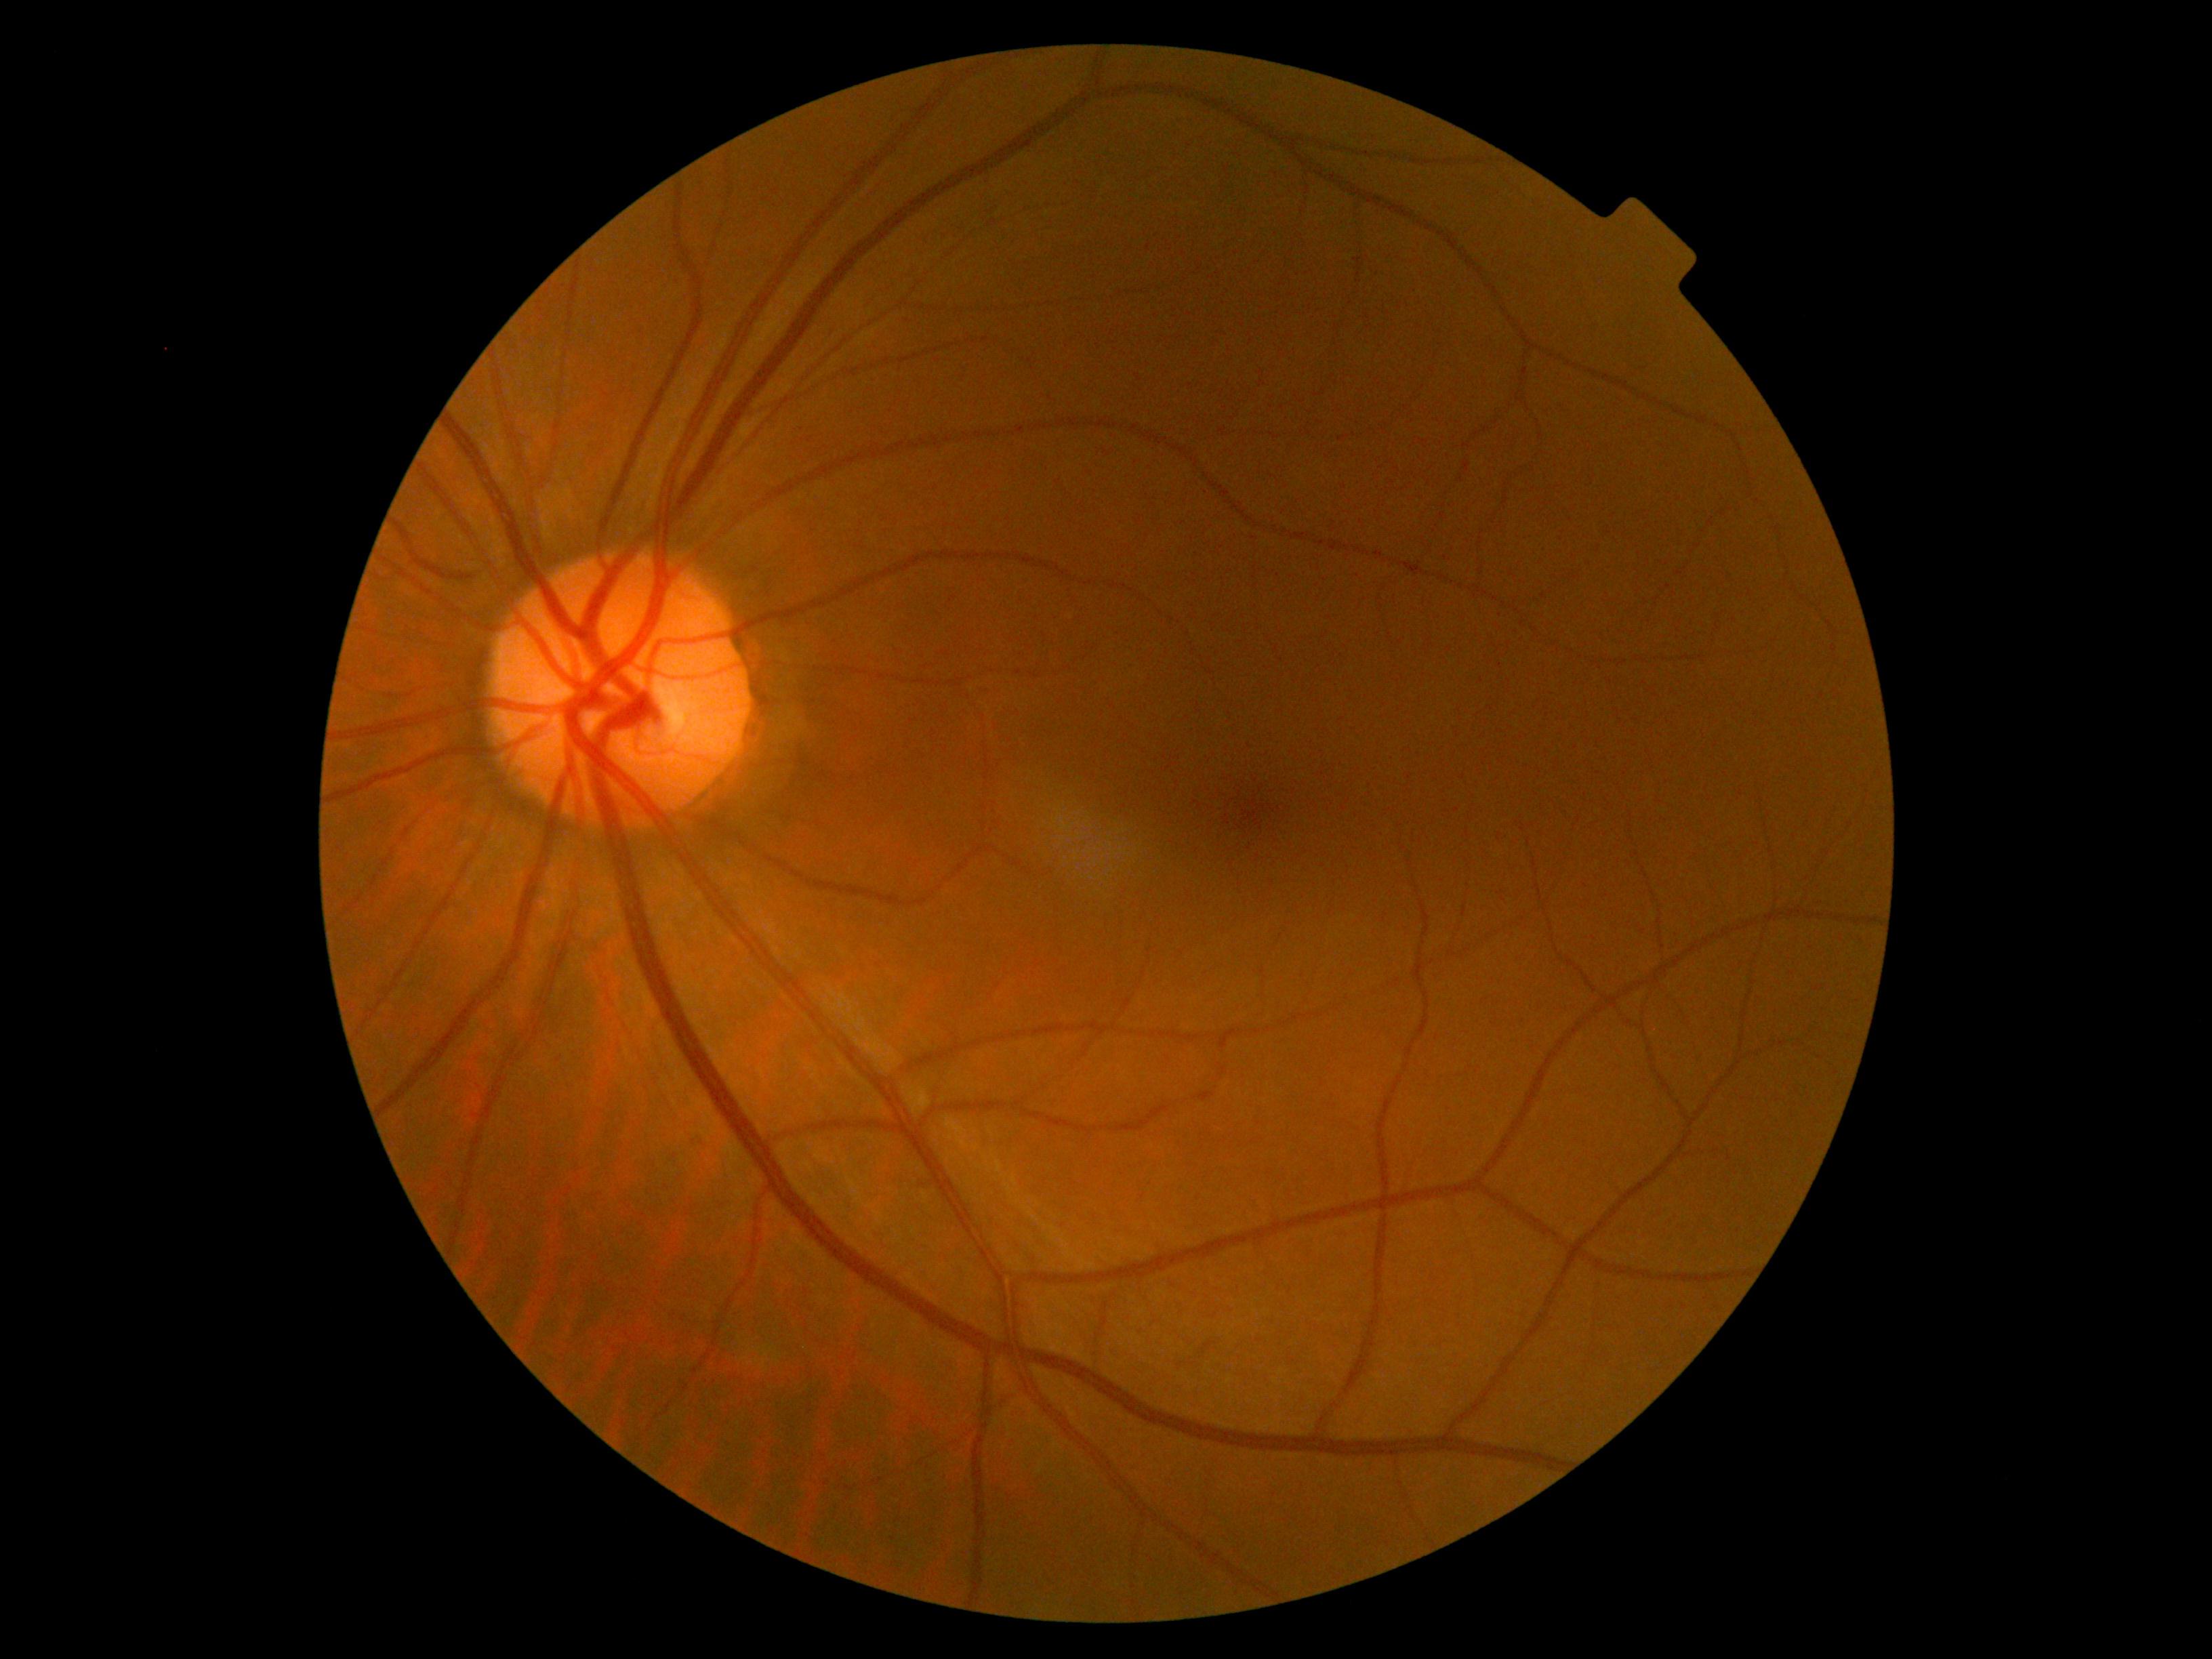 dr_grade: no apparent retinopathy (grade 0)